Acquired with a Topcon TRC-NW400; image size 2212x1661; retinal fundus photograph; undilated pupil:
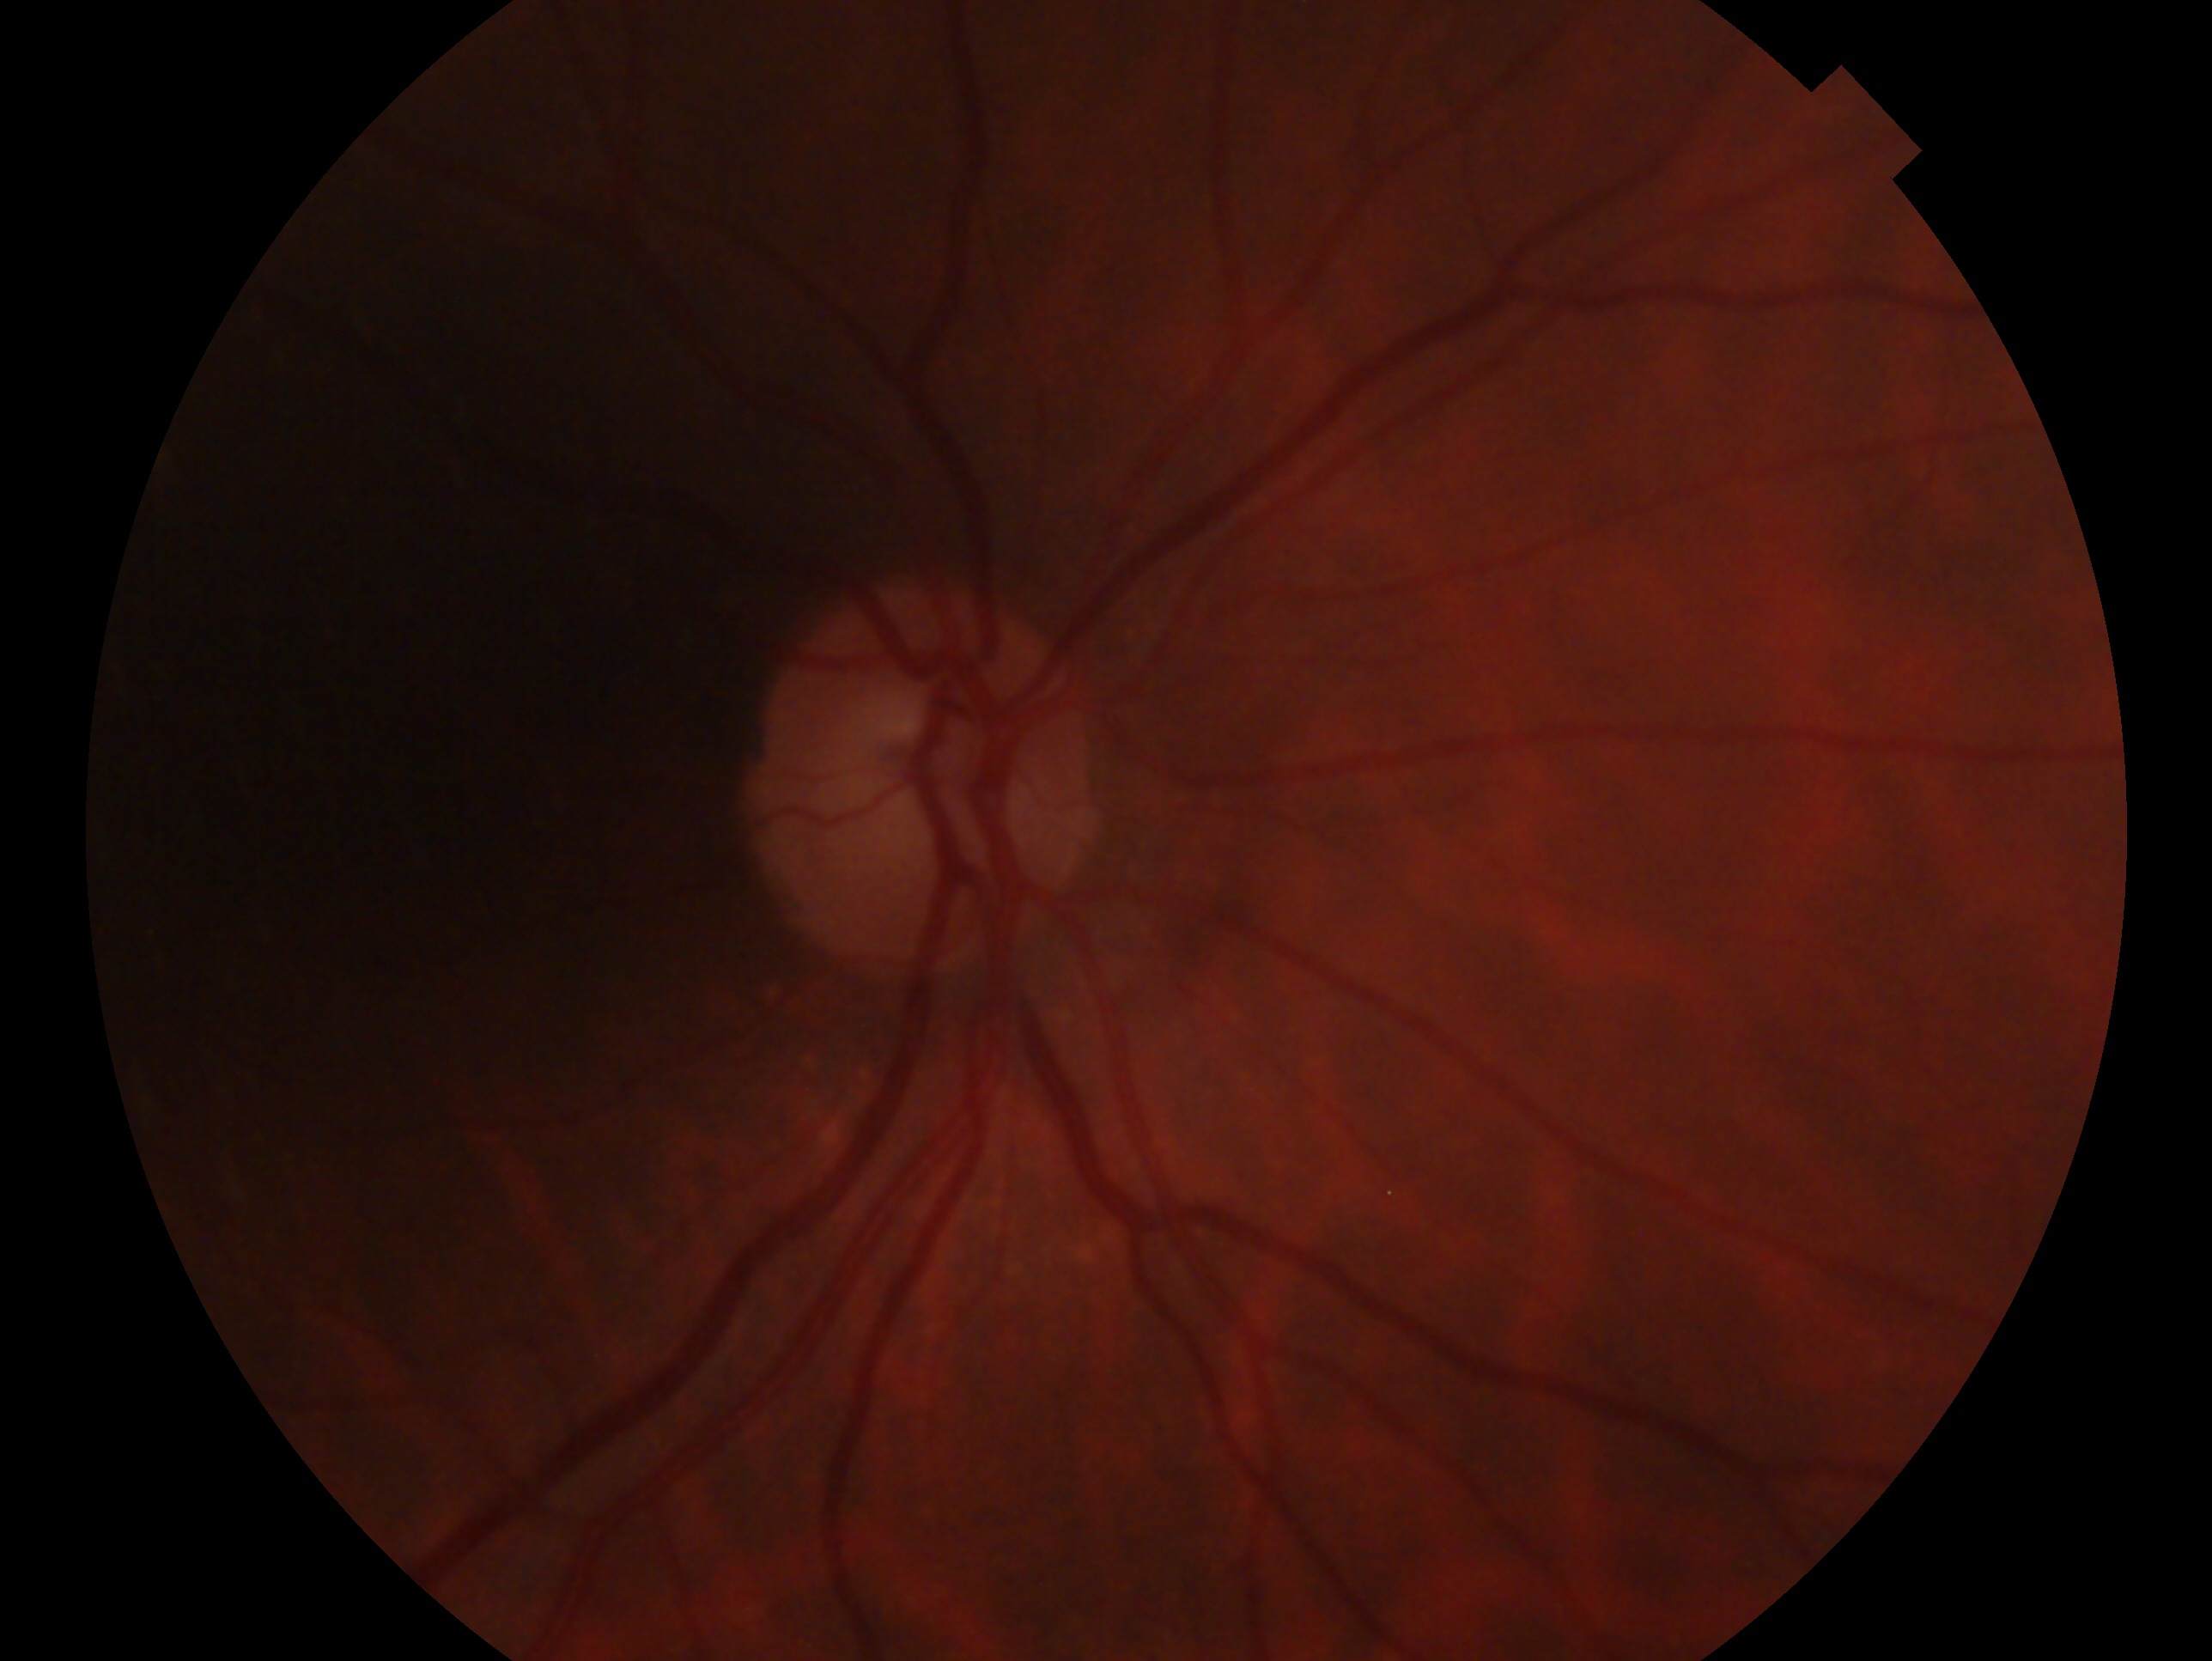   eye: oculus dexter
  glaucoma_dx: possible glaucoma